848 by 848 pixels, posterior pole photograph, 45 degree fundus photograph, NIDEK AFC-230
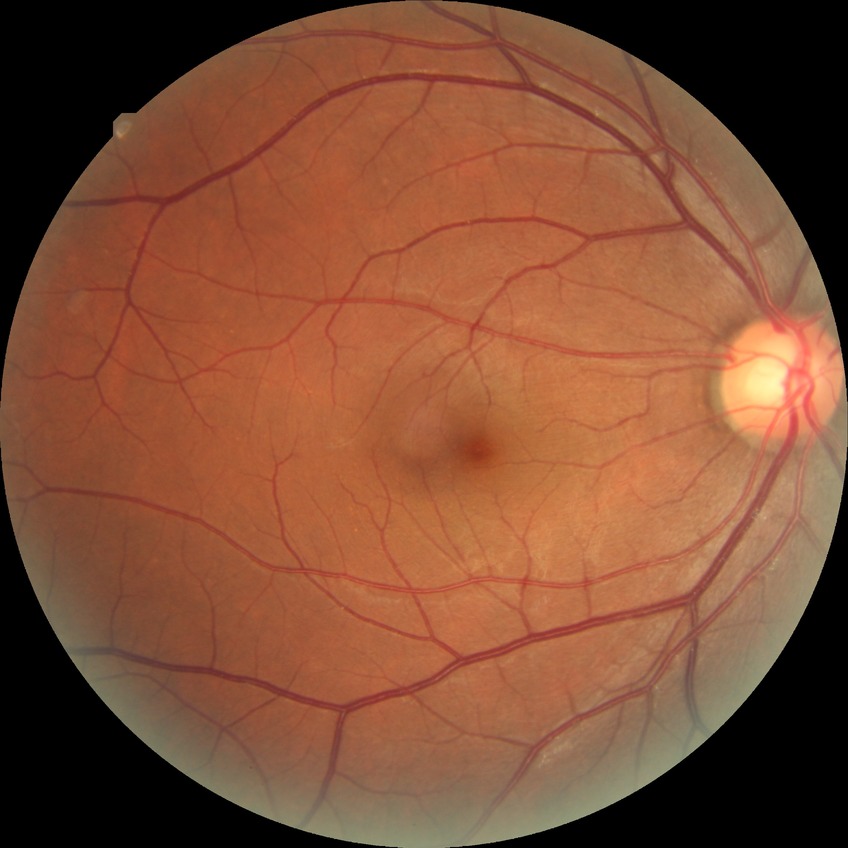 diabetic retinopathy (DR)@NDR (no diabetic retinopathy).